Ultra-widefield fundus photograph.
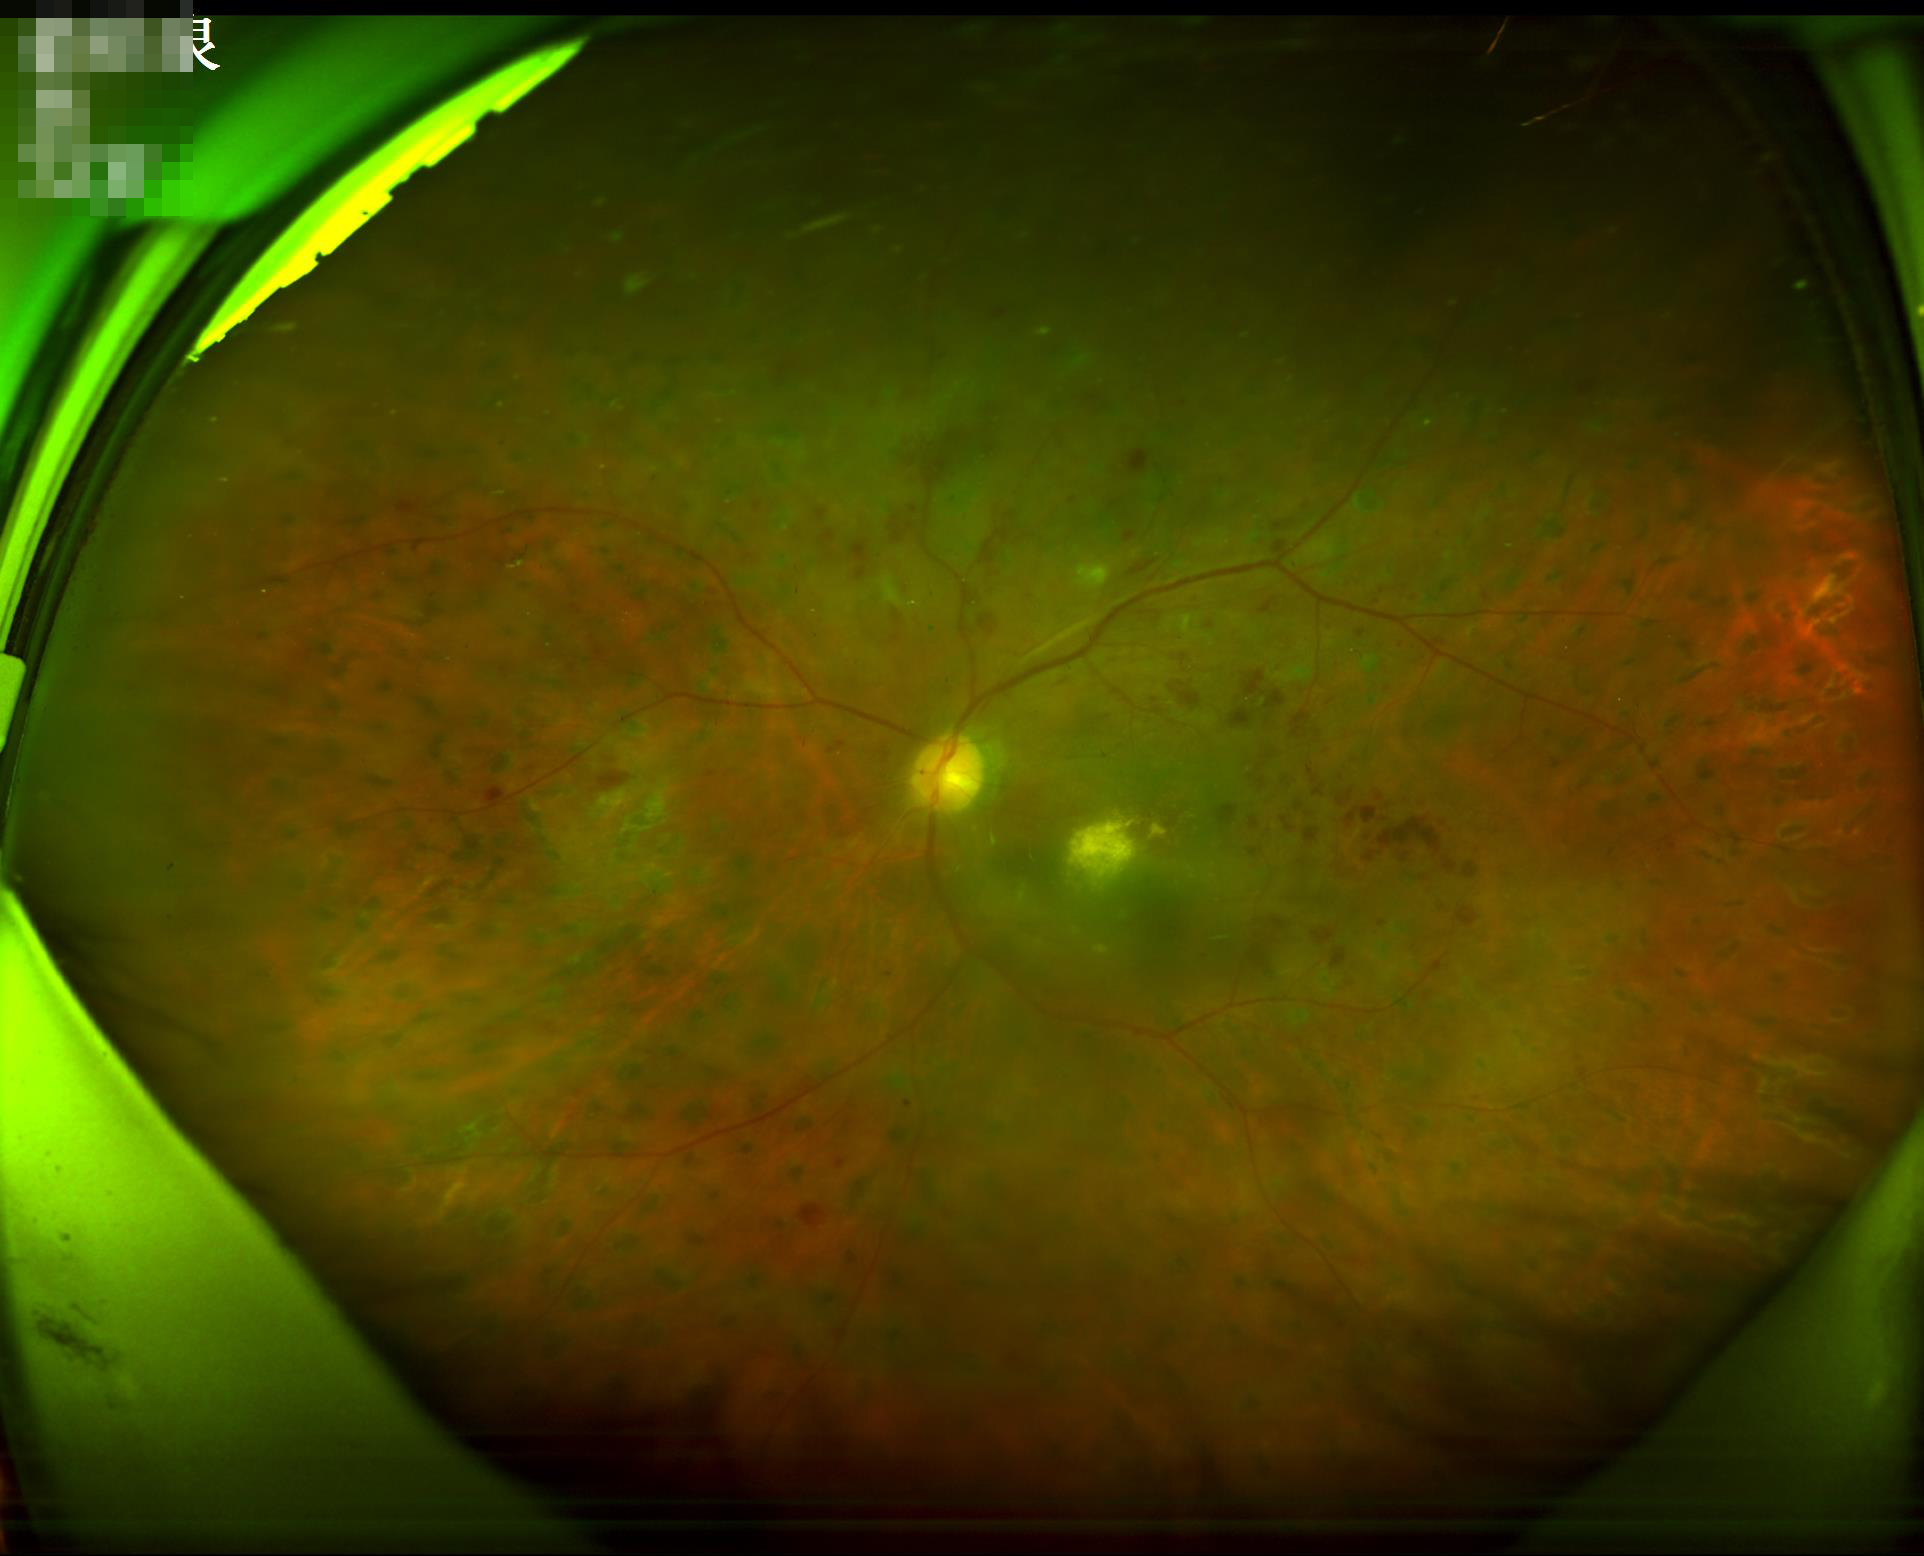

Good dynamic range.
Illumination is even.
Overall image quality is good.
Image is sharp throughout the field.